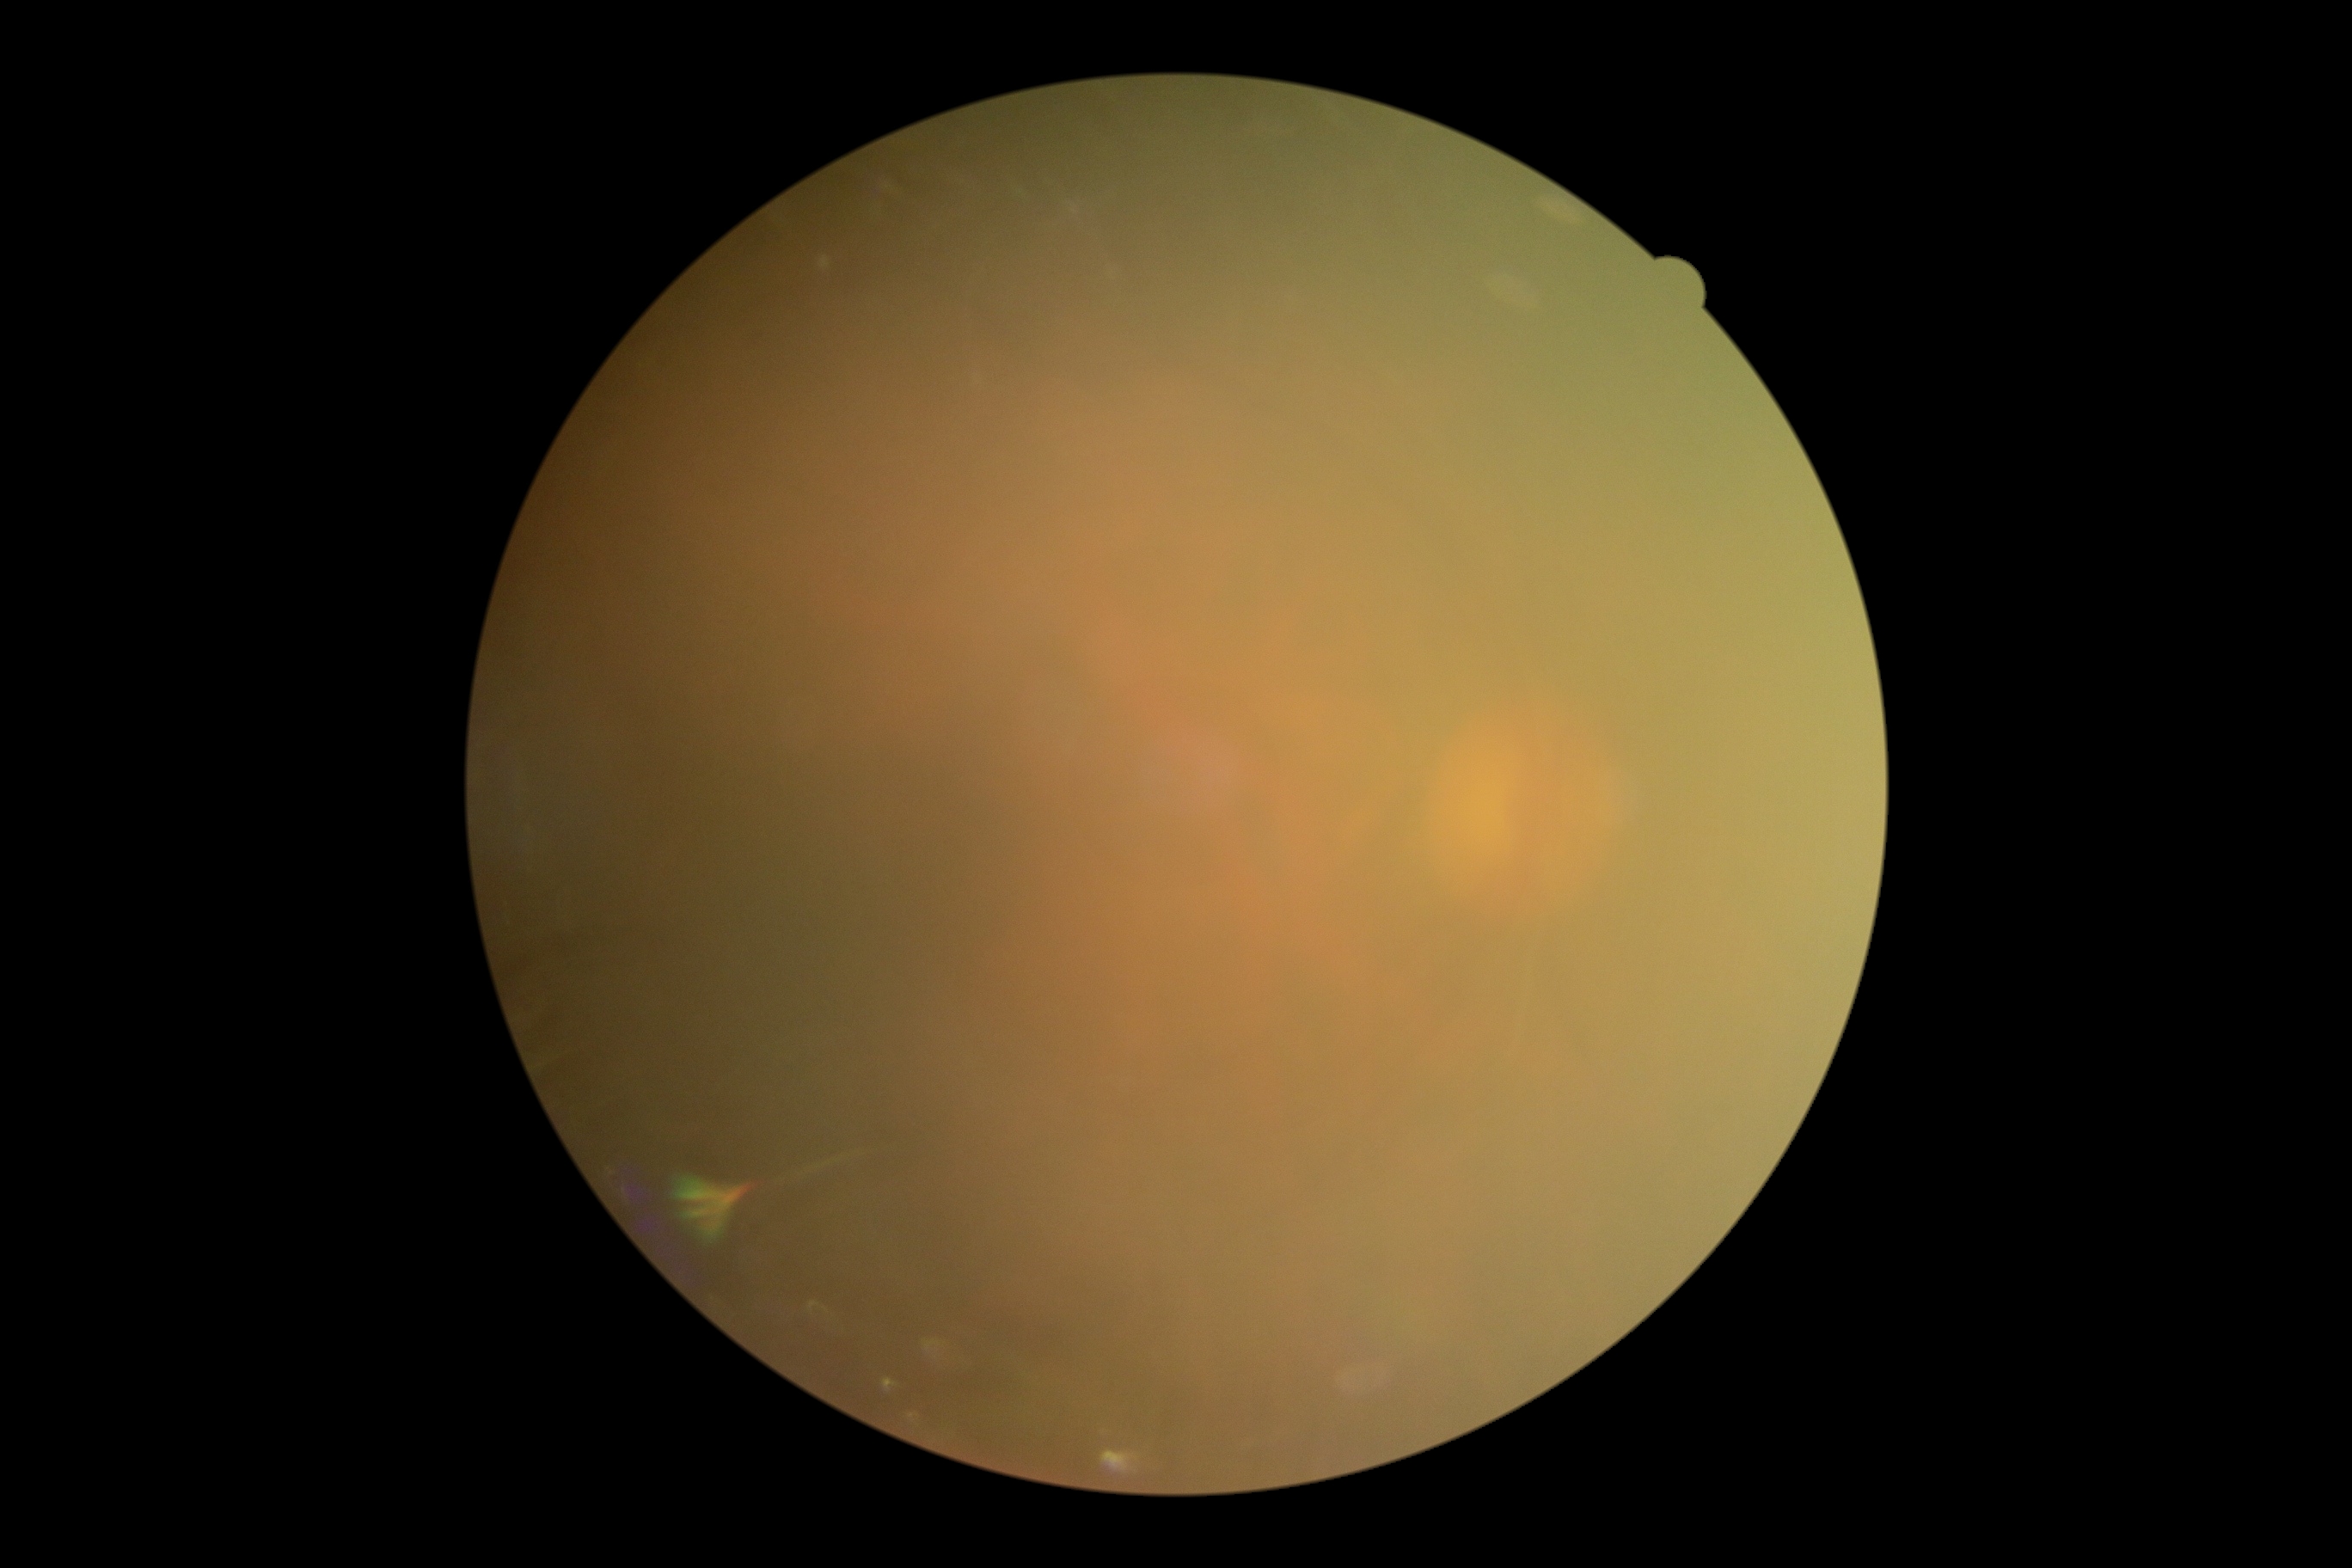

{"dr_grade": "ungradable", "quality": "insufficient"}